Image size 1932x1932.
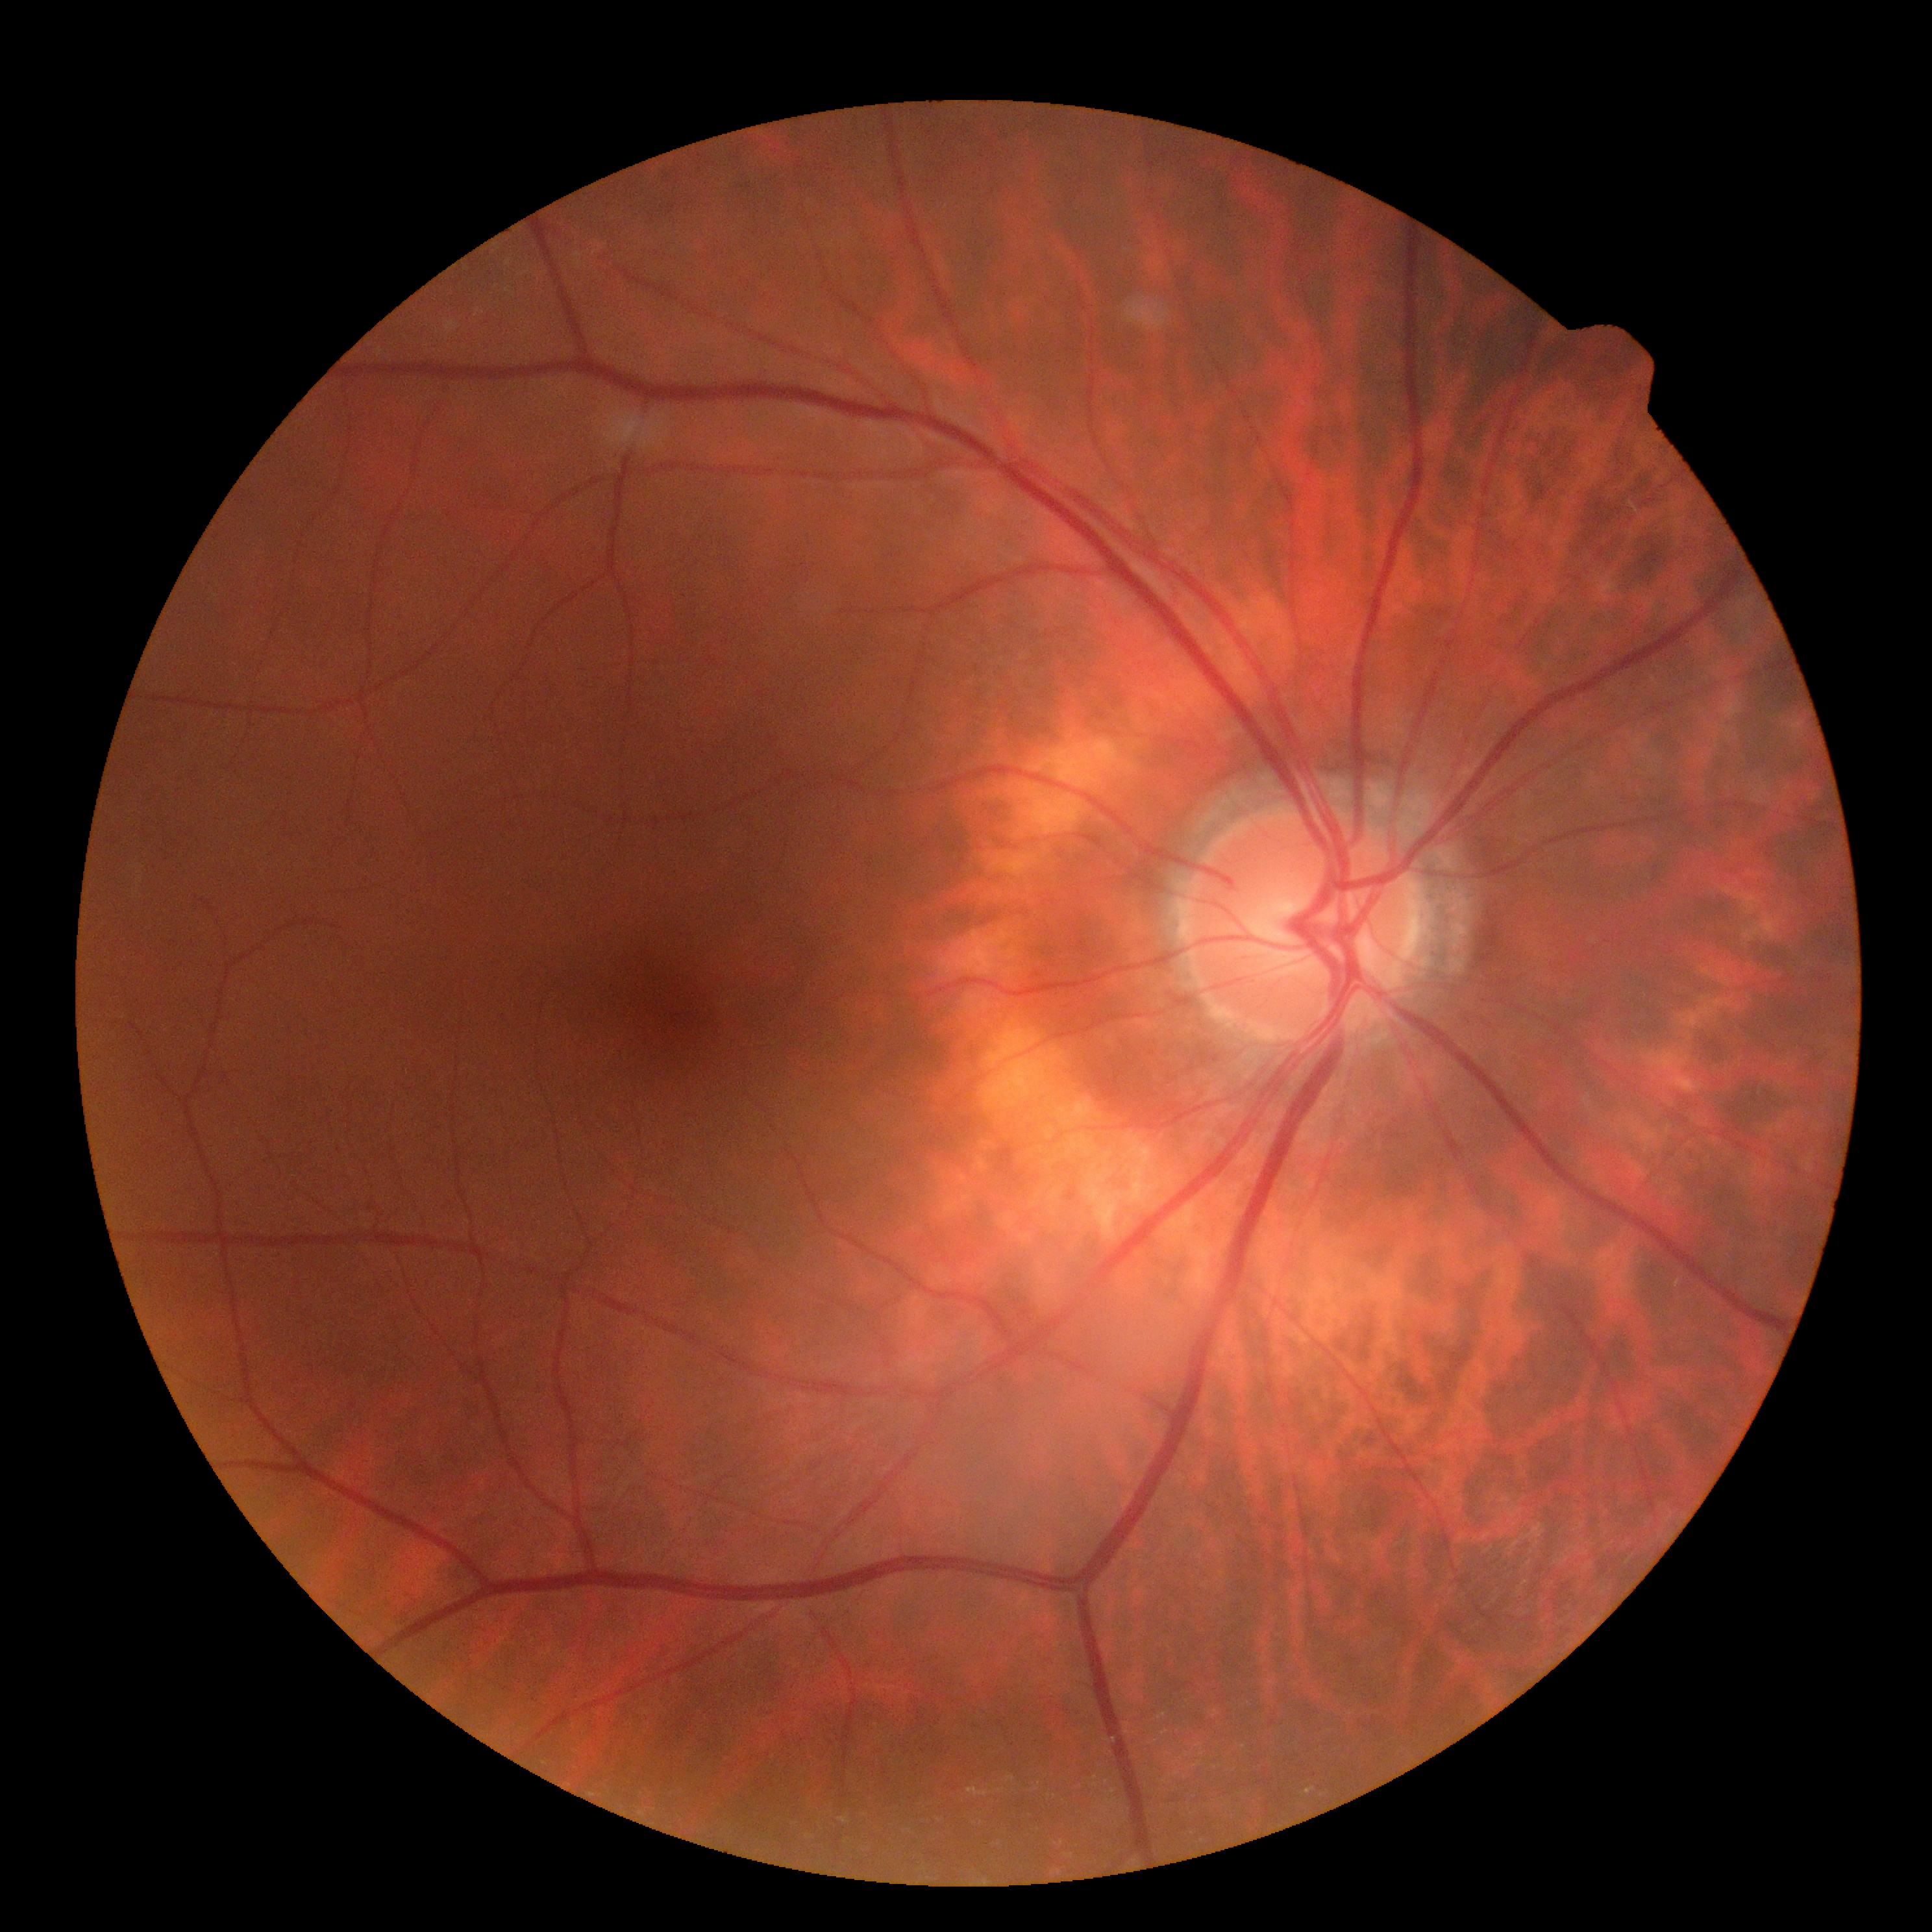

Retinopathy: grade 0 (no apparent retinopathy).